Image size 1470x1472, CFP, 45° FOV — 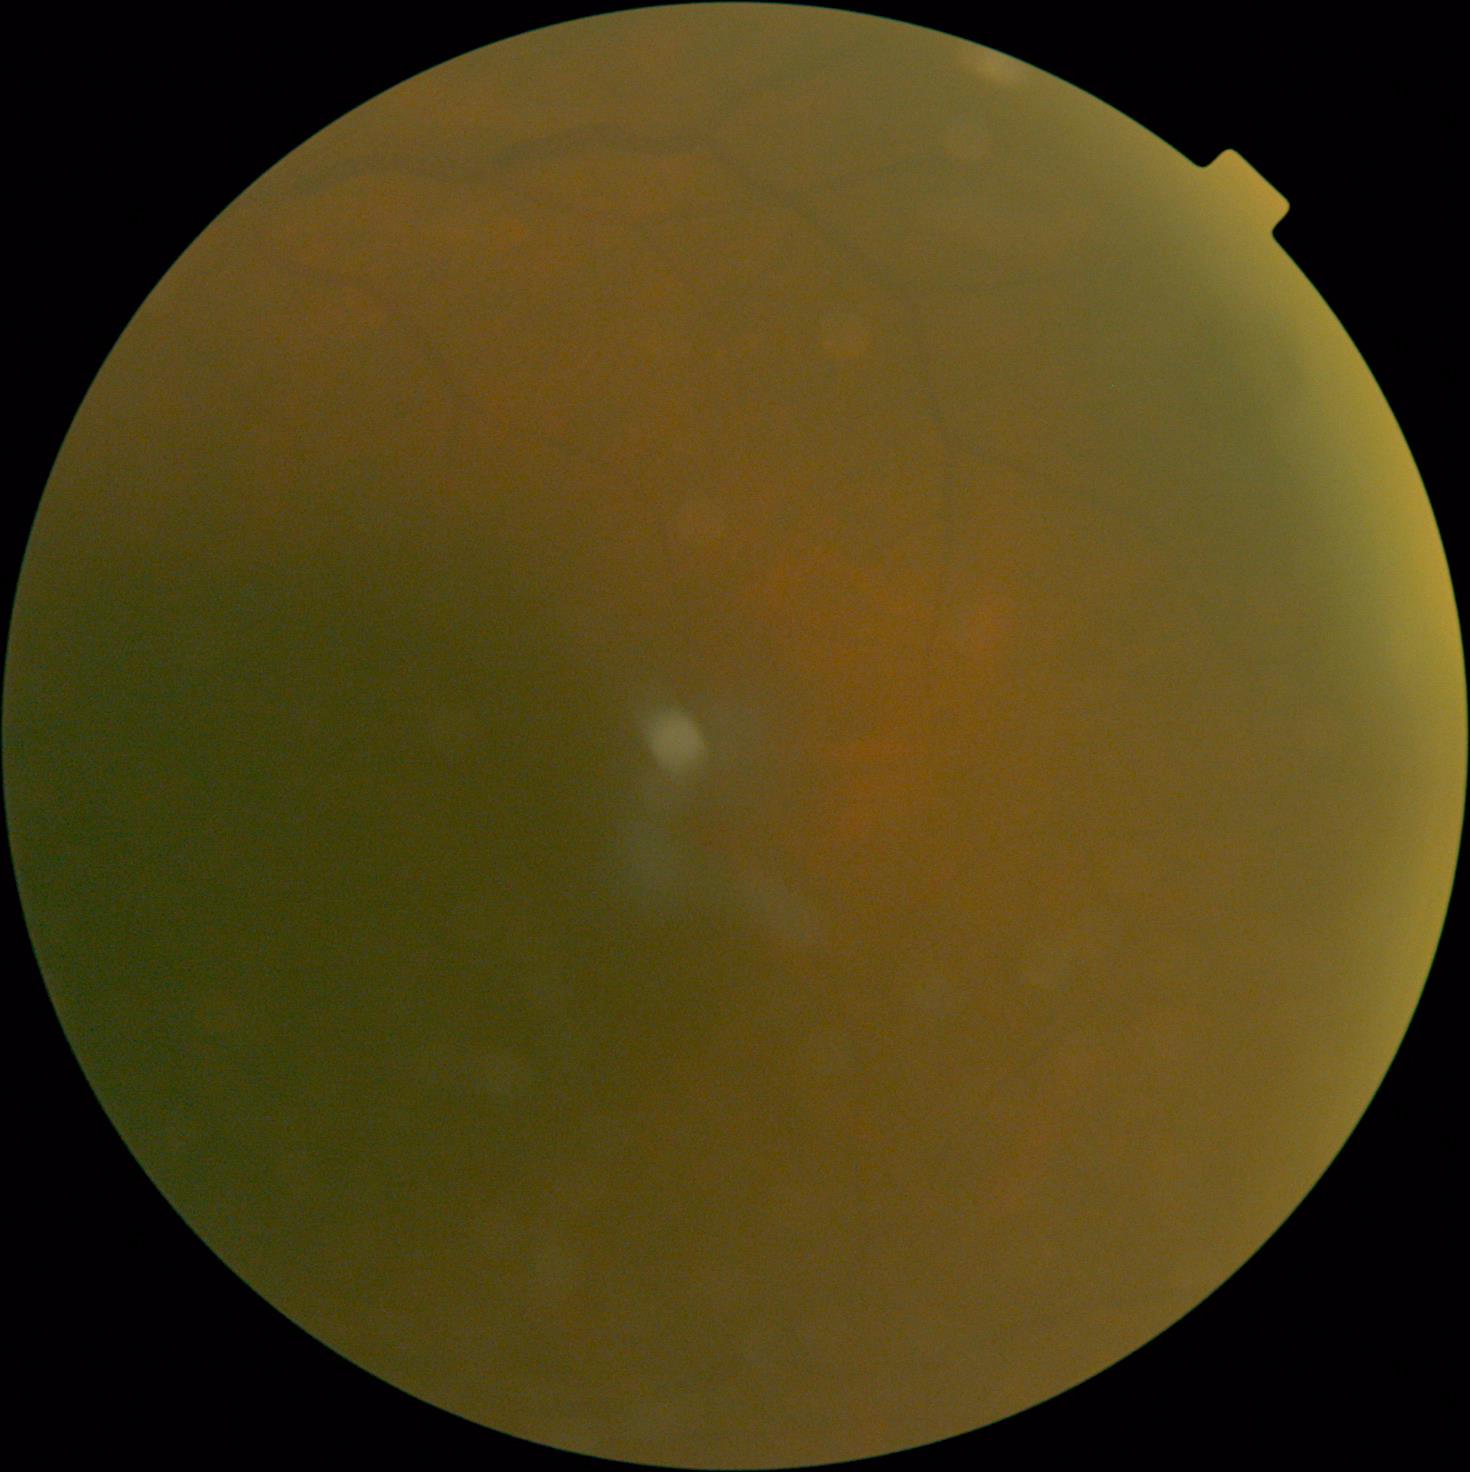 Diabetic retinopathy severity is ungradable due to poor image quality.